Posterior pole color fundus photograph; 848x848px; nonmydriatic fundus photograph — 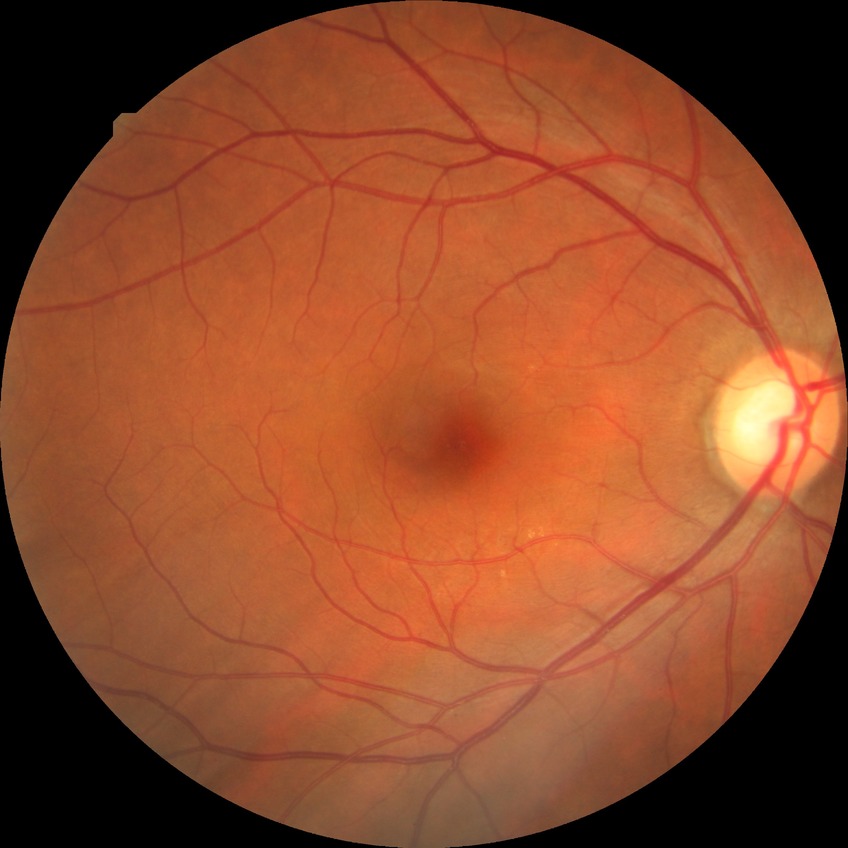

Diabetic retinopathy (DR) is NDR (no diabetic retinopathy).